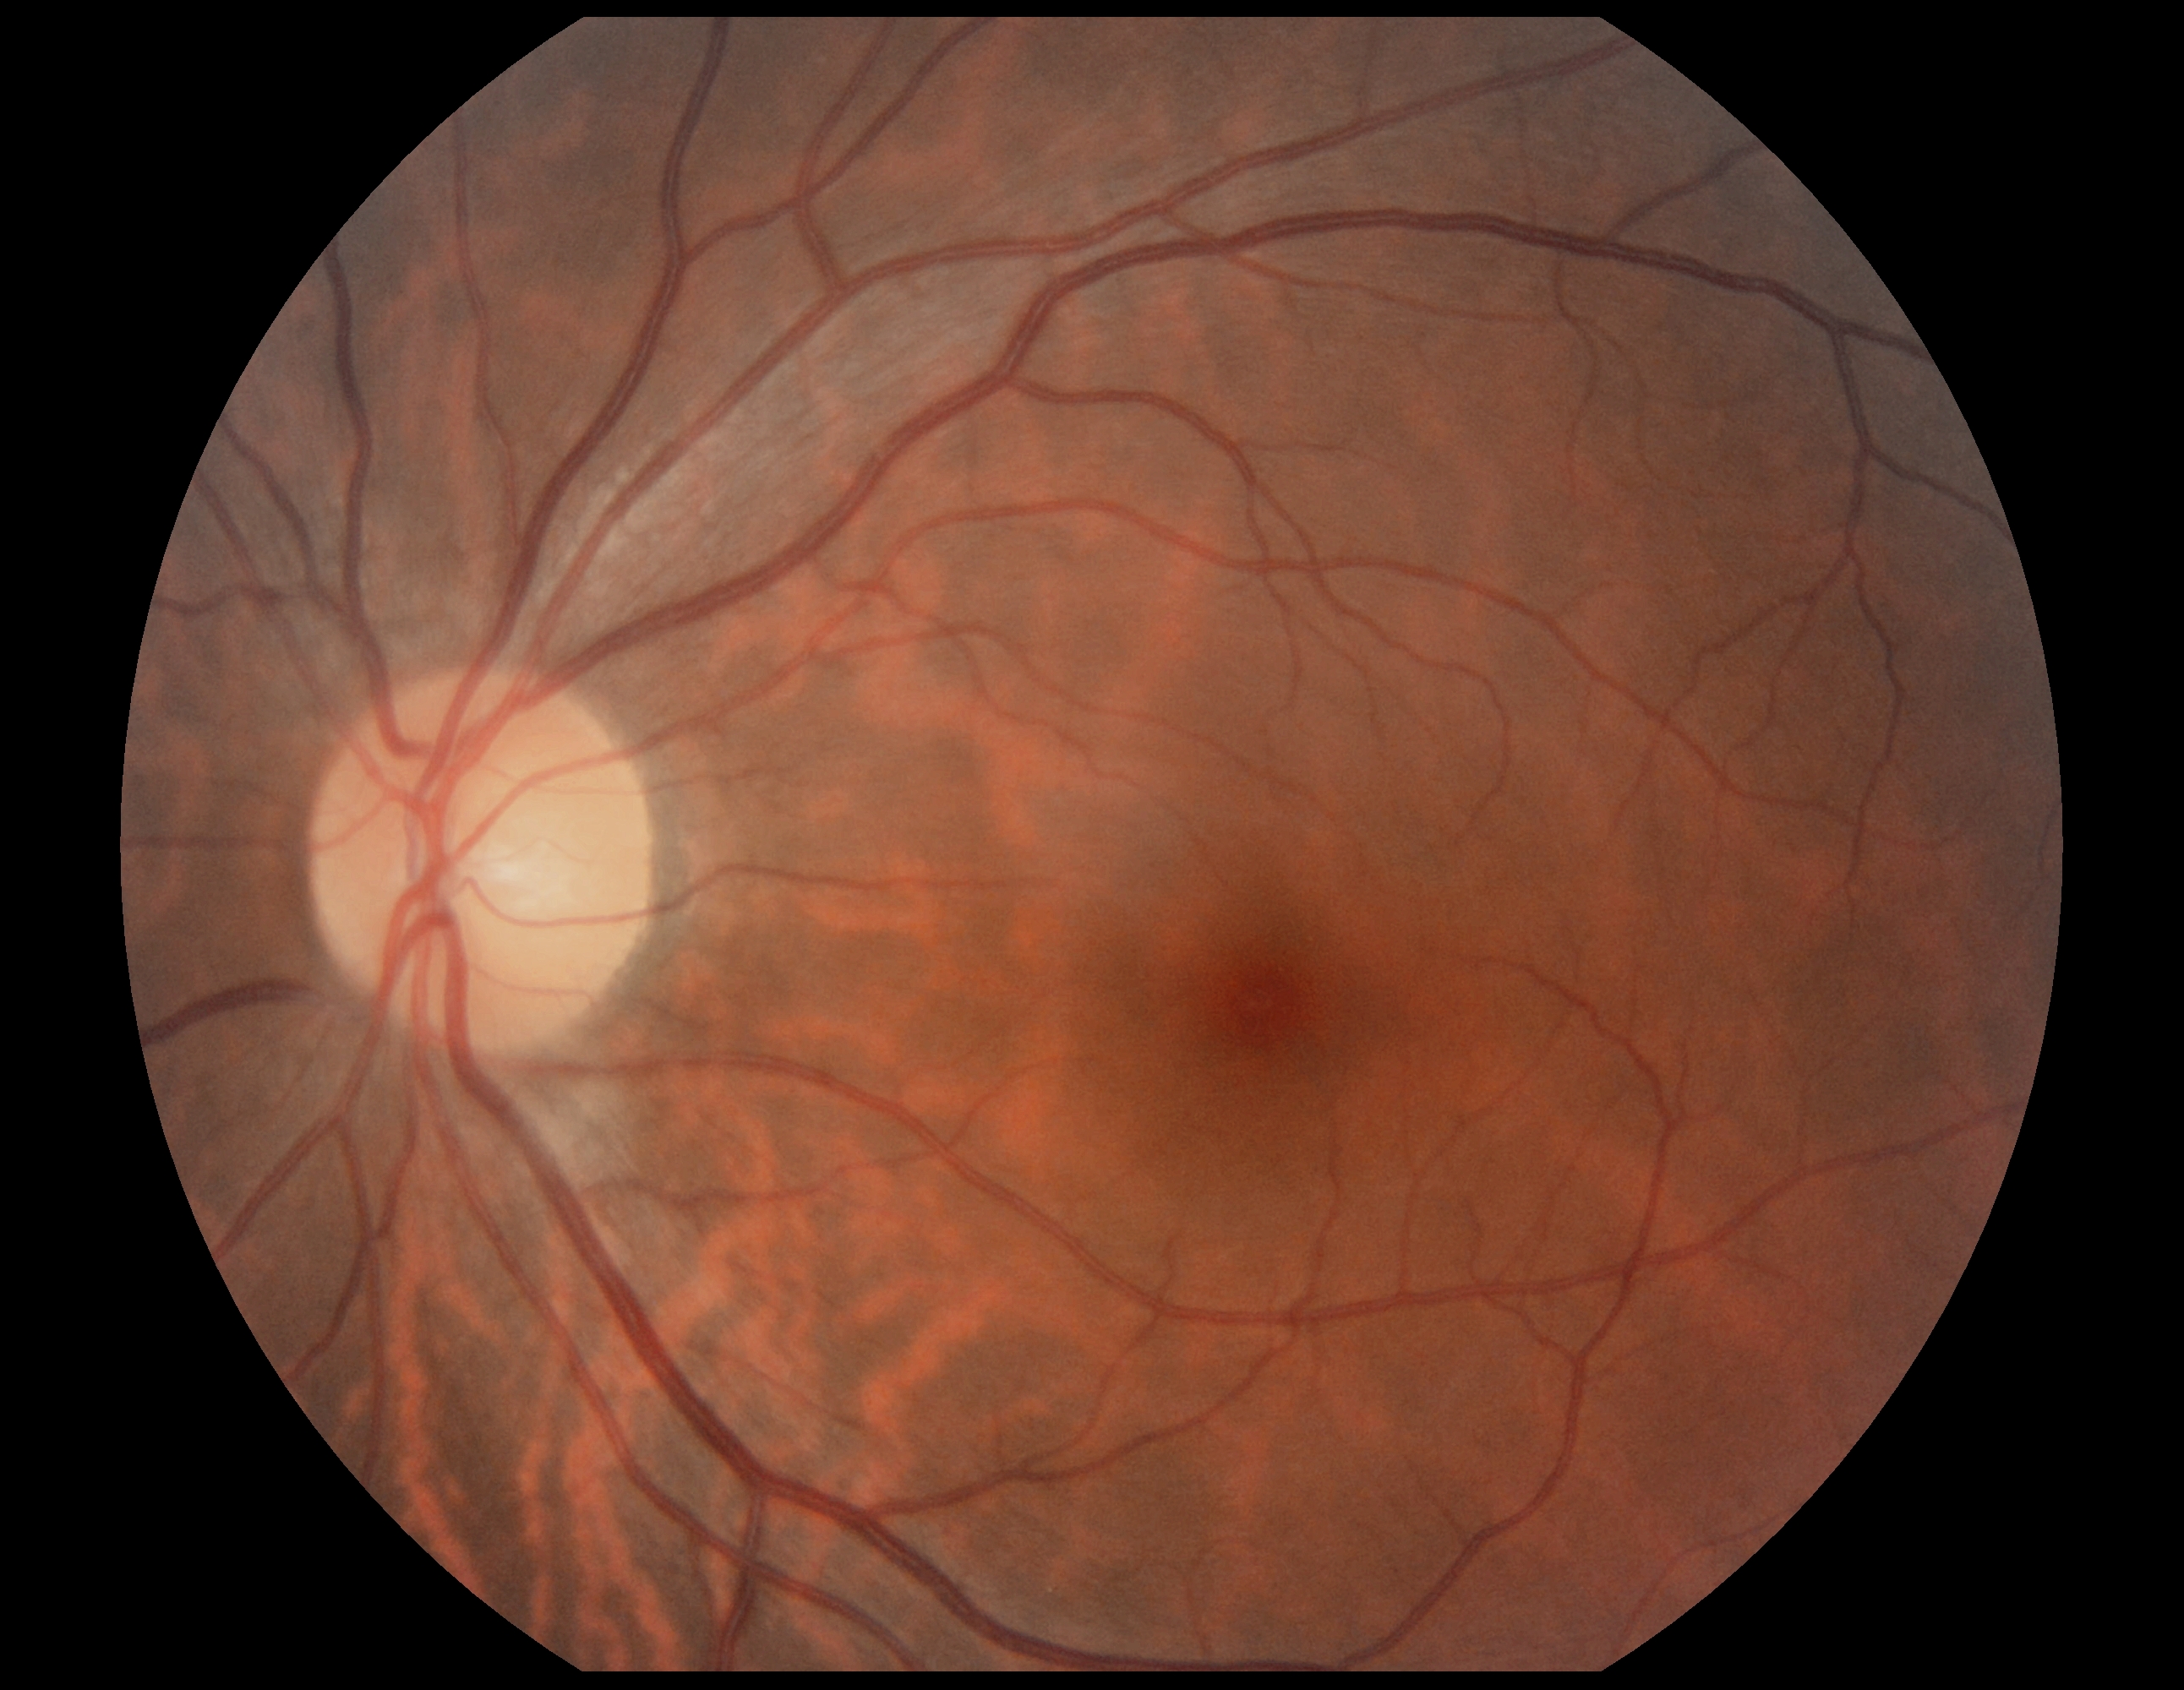

- DR grade — 0/4
- DR impression — no DR findings